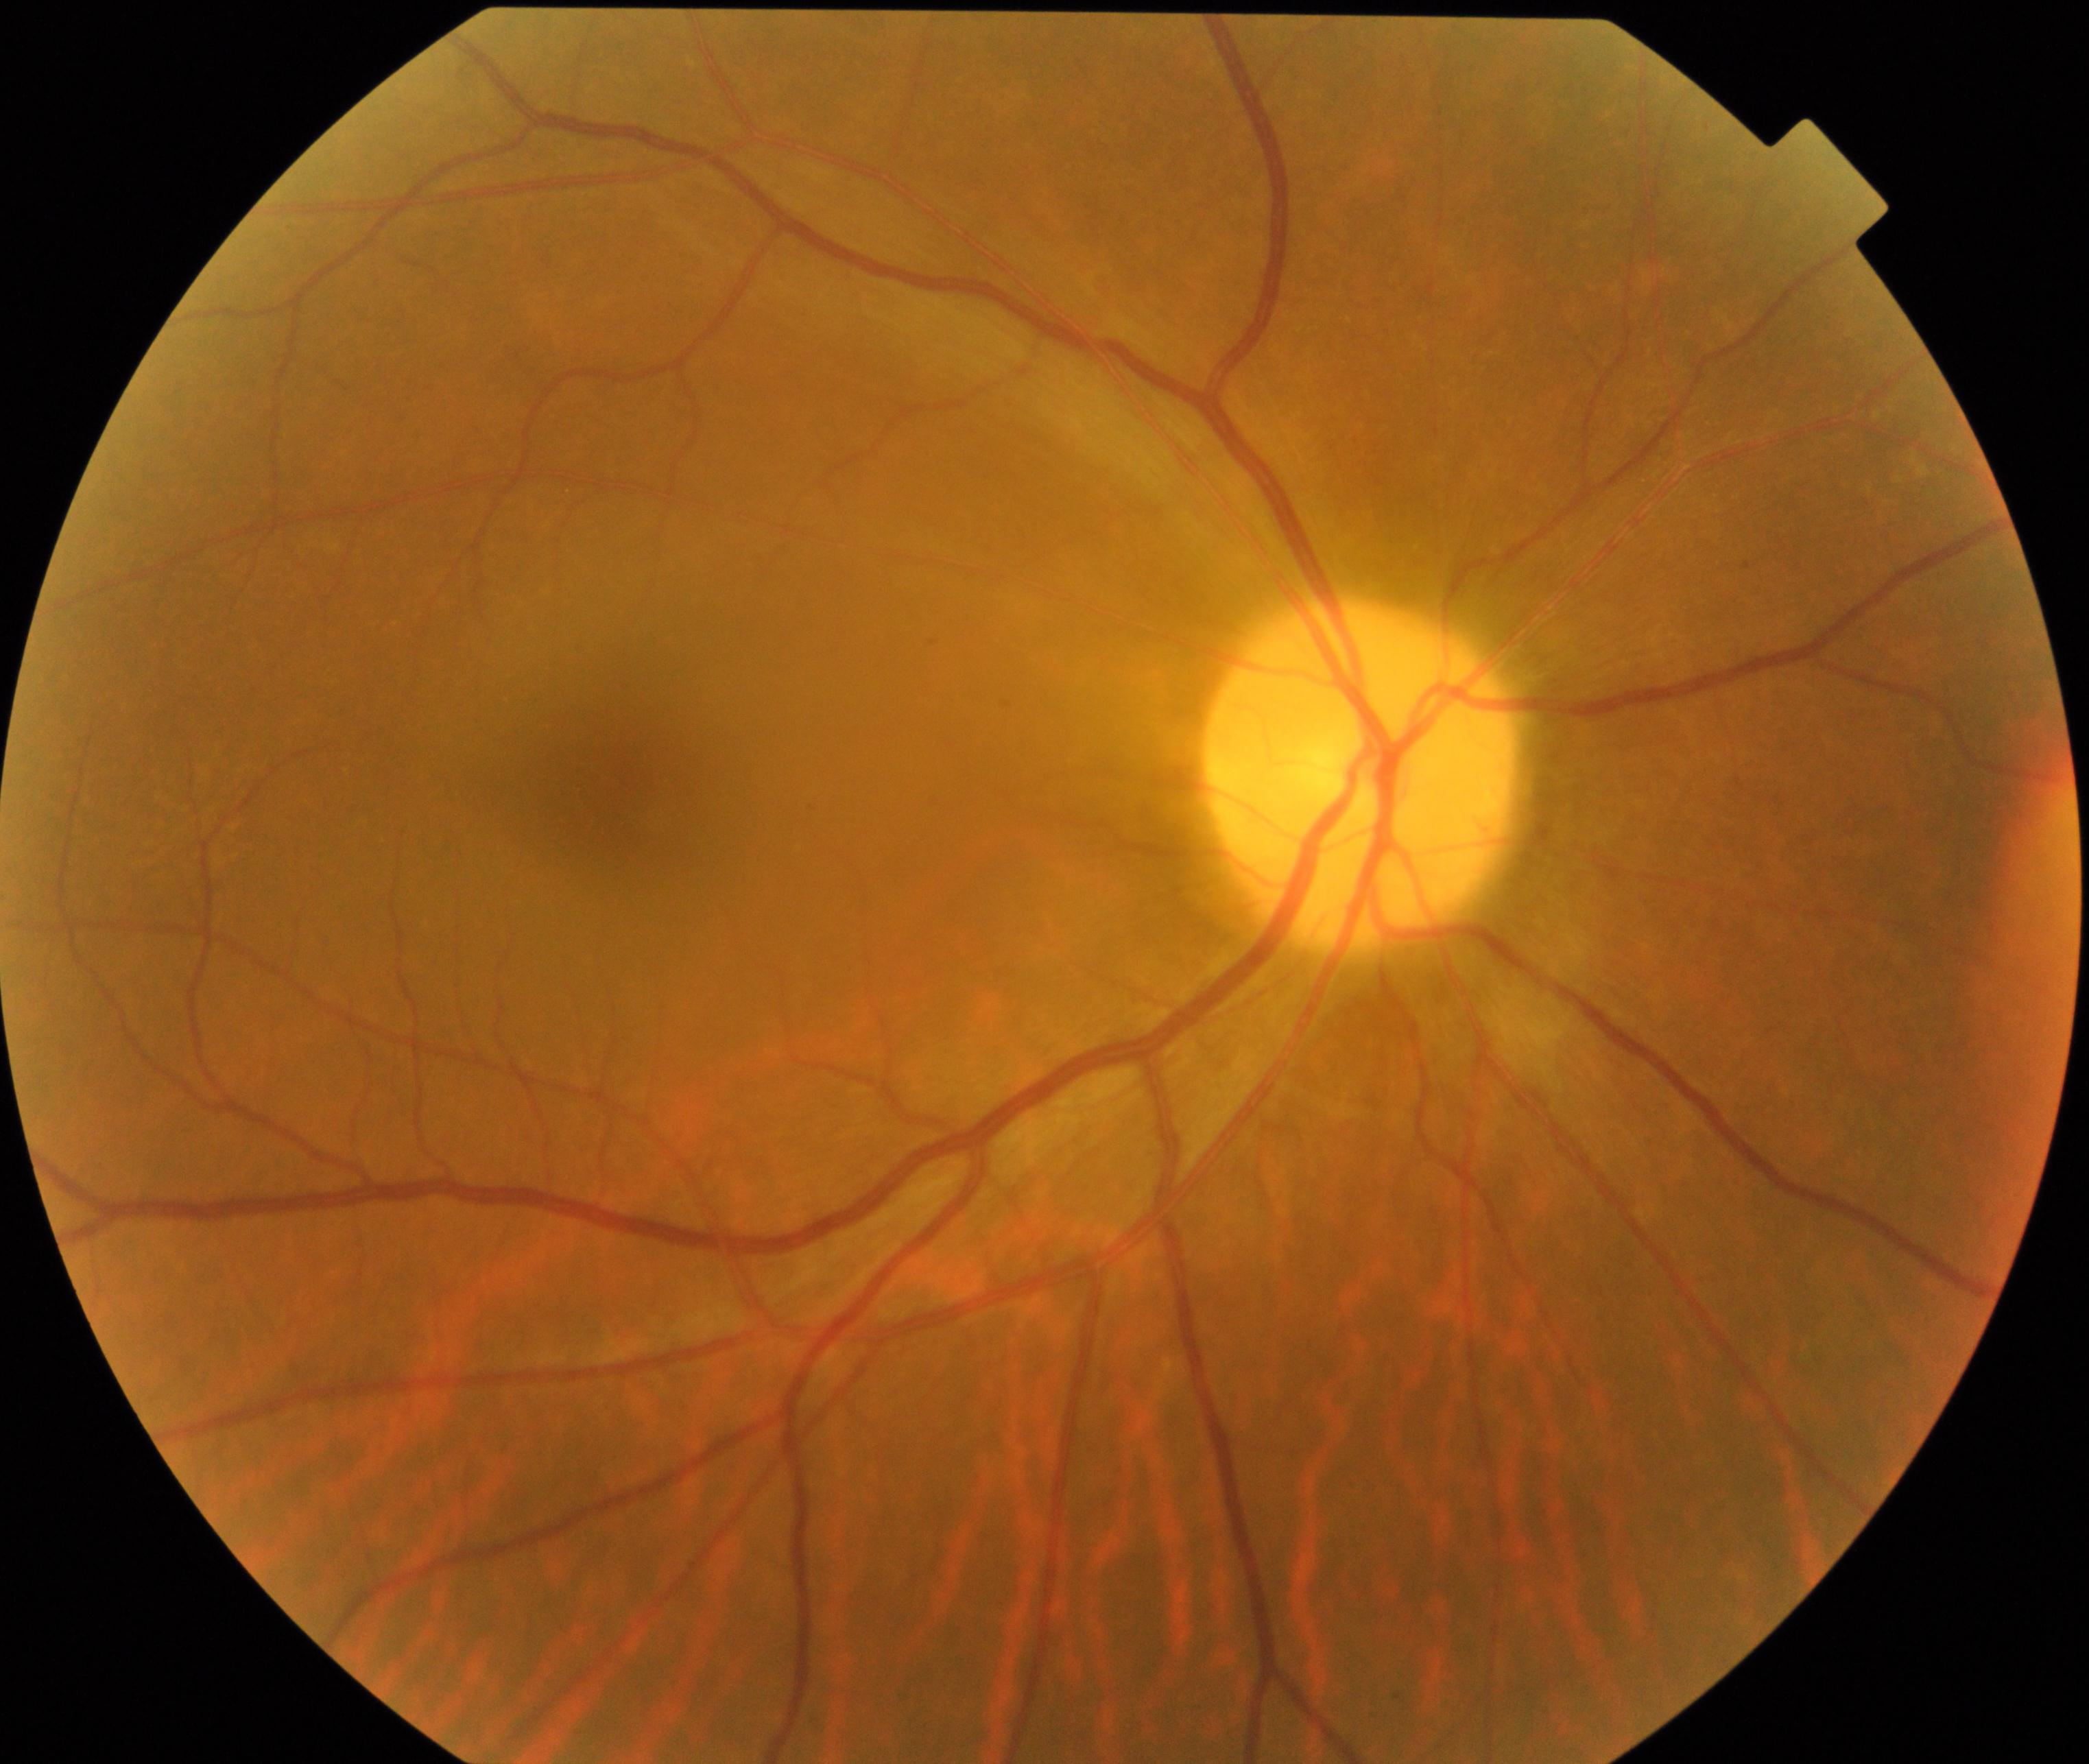

Appearance consistent with optic atrophy.